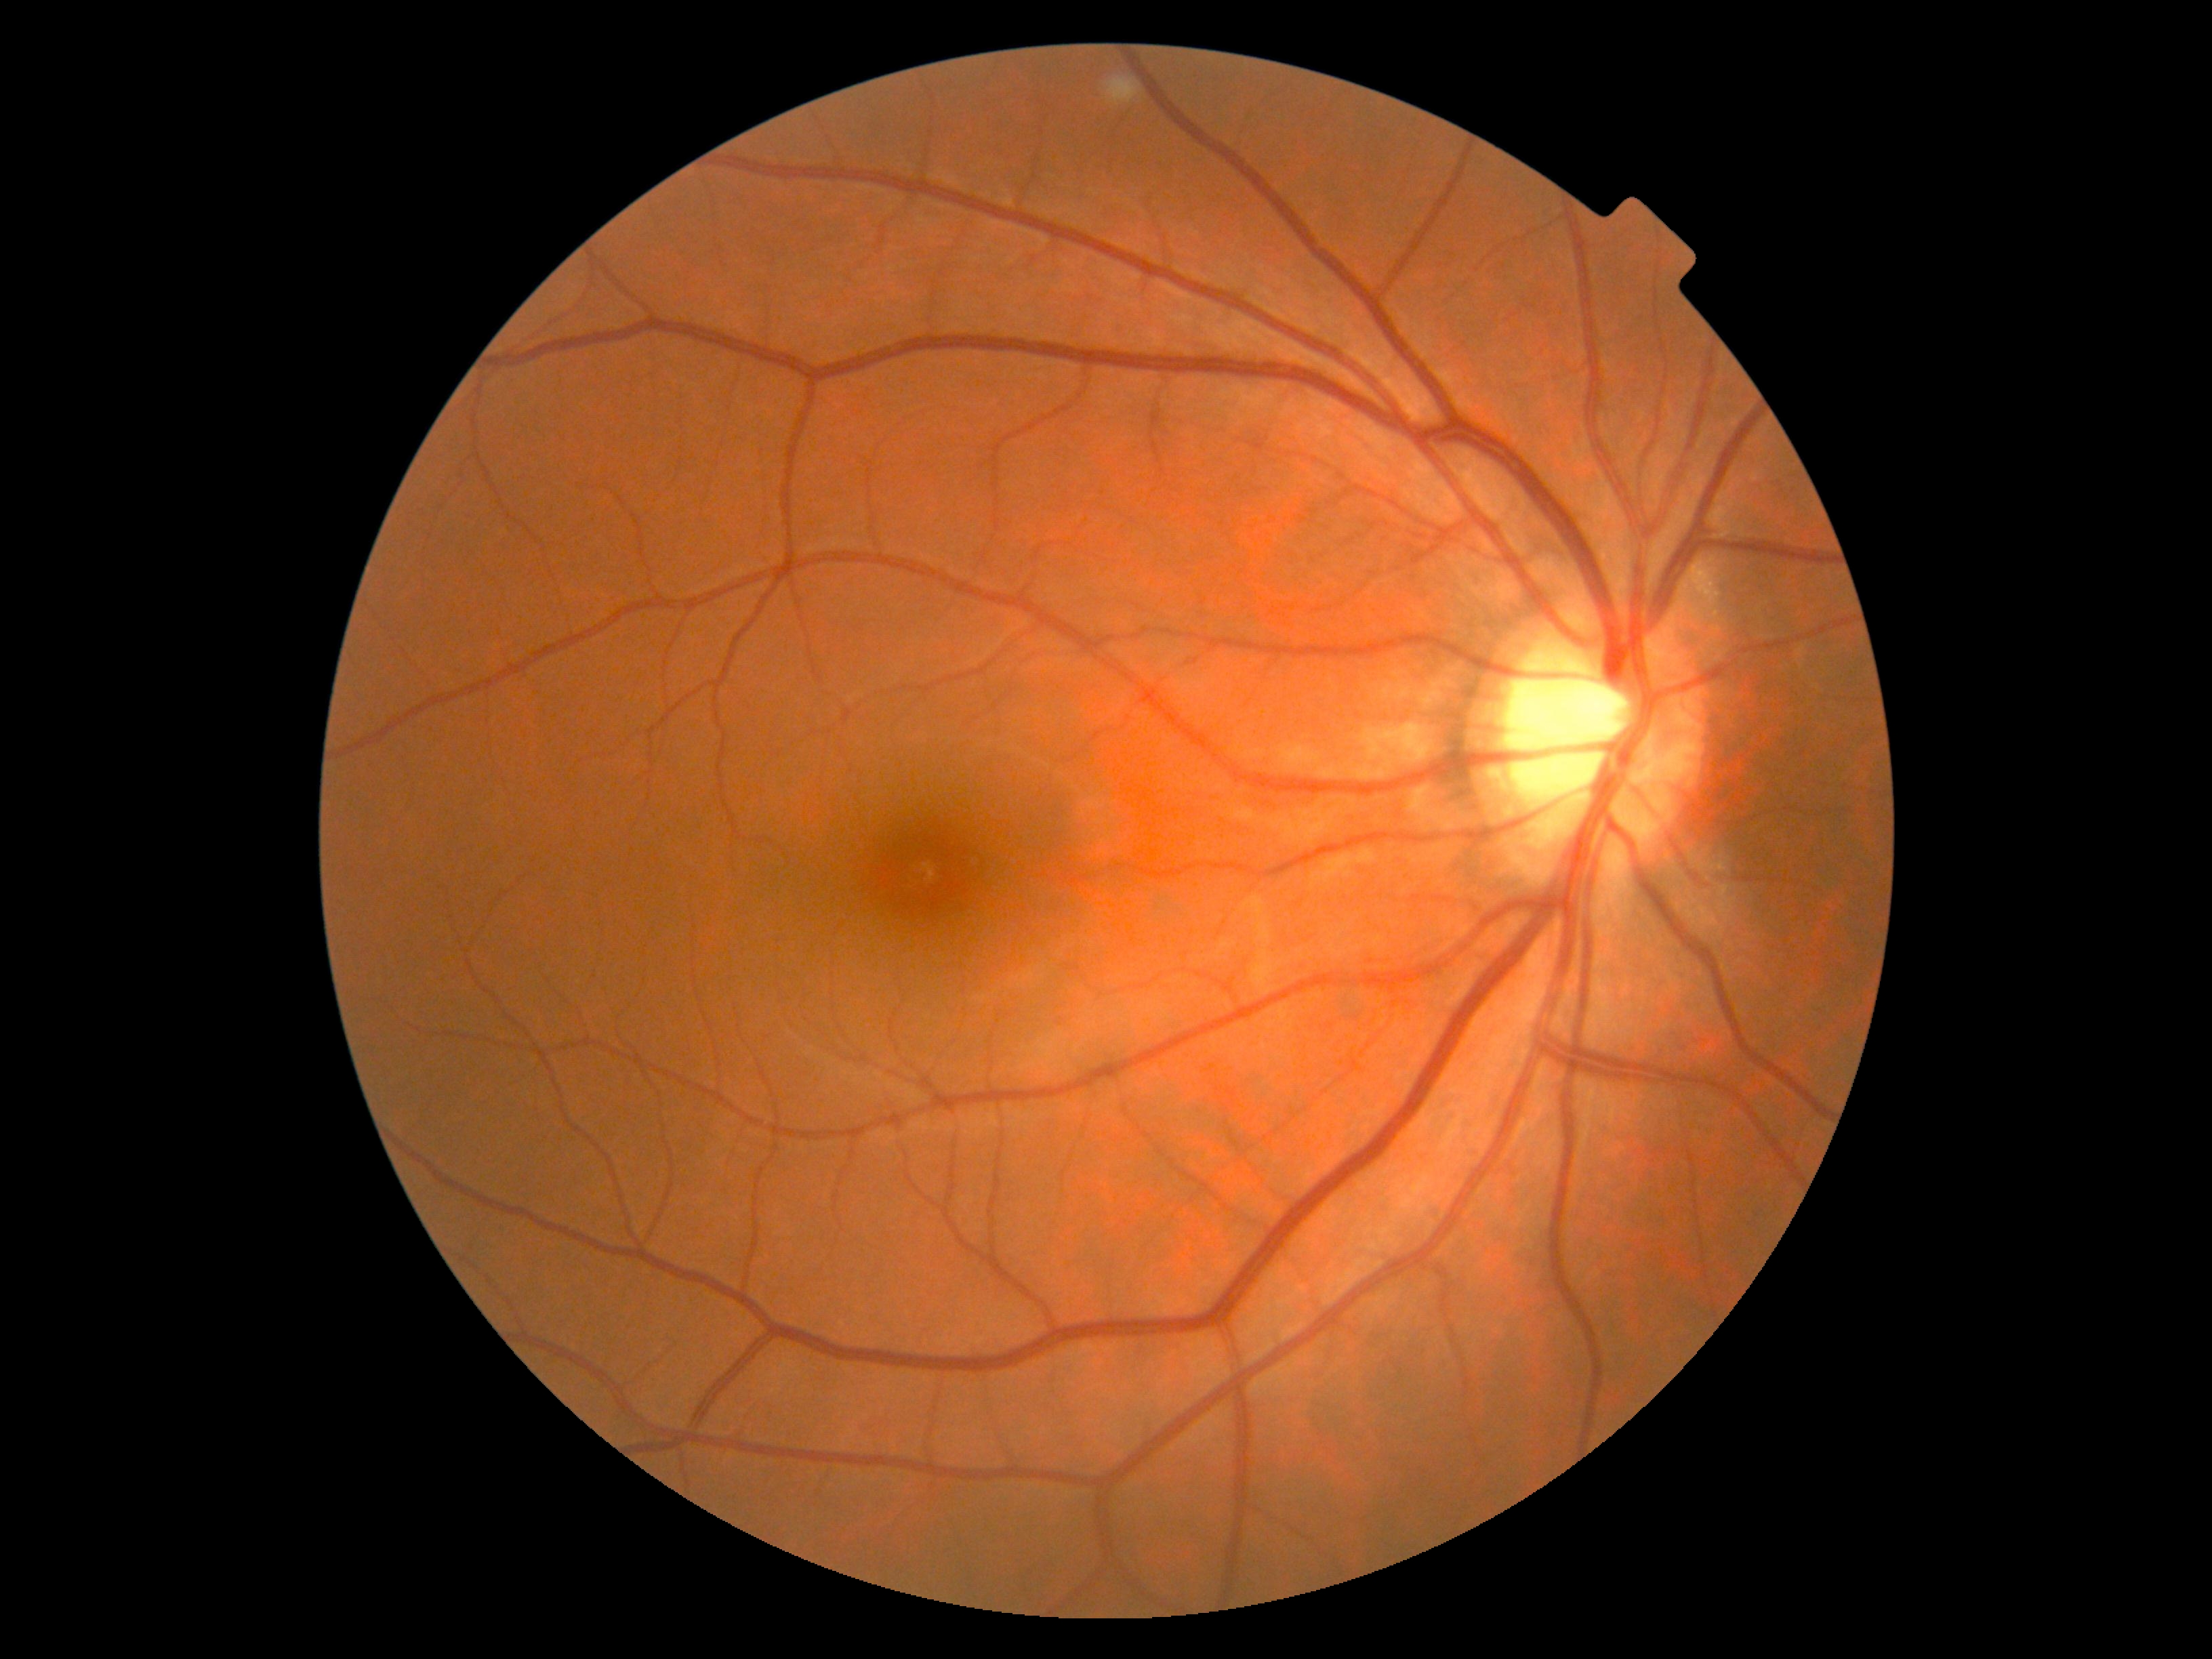

Annotations:
• diabetic retinopathy (DR): 0
• DR impression: negative for DR